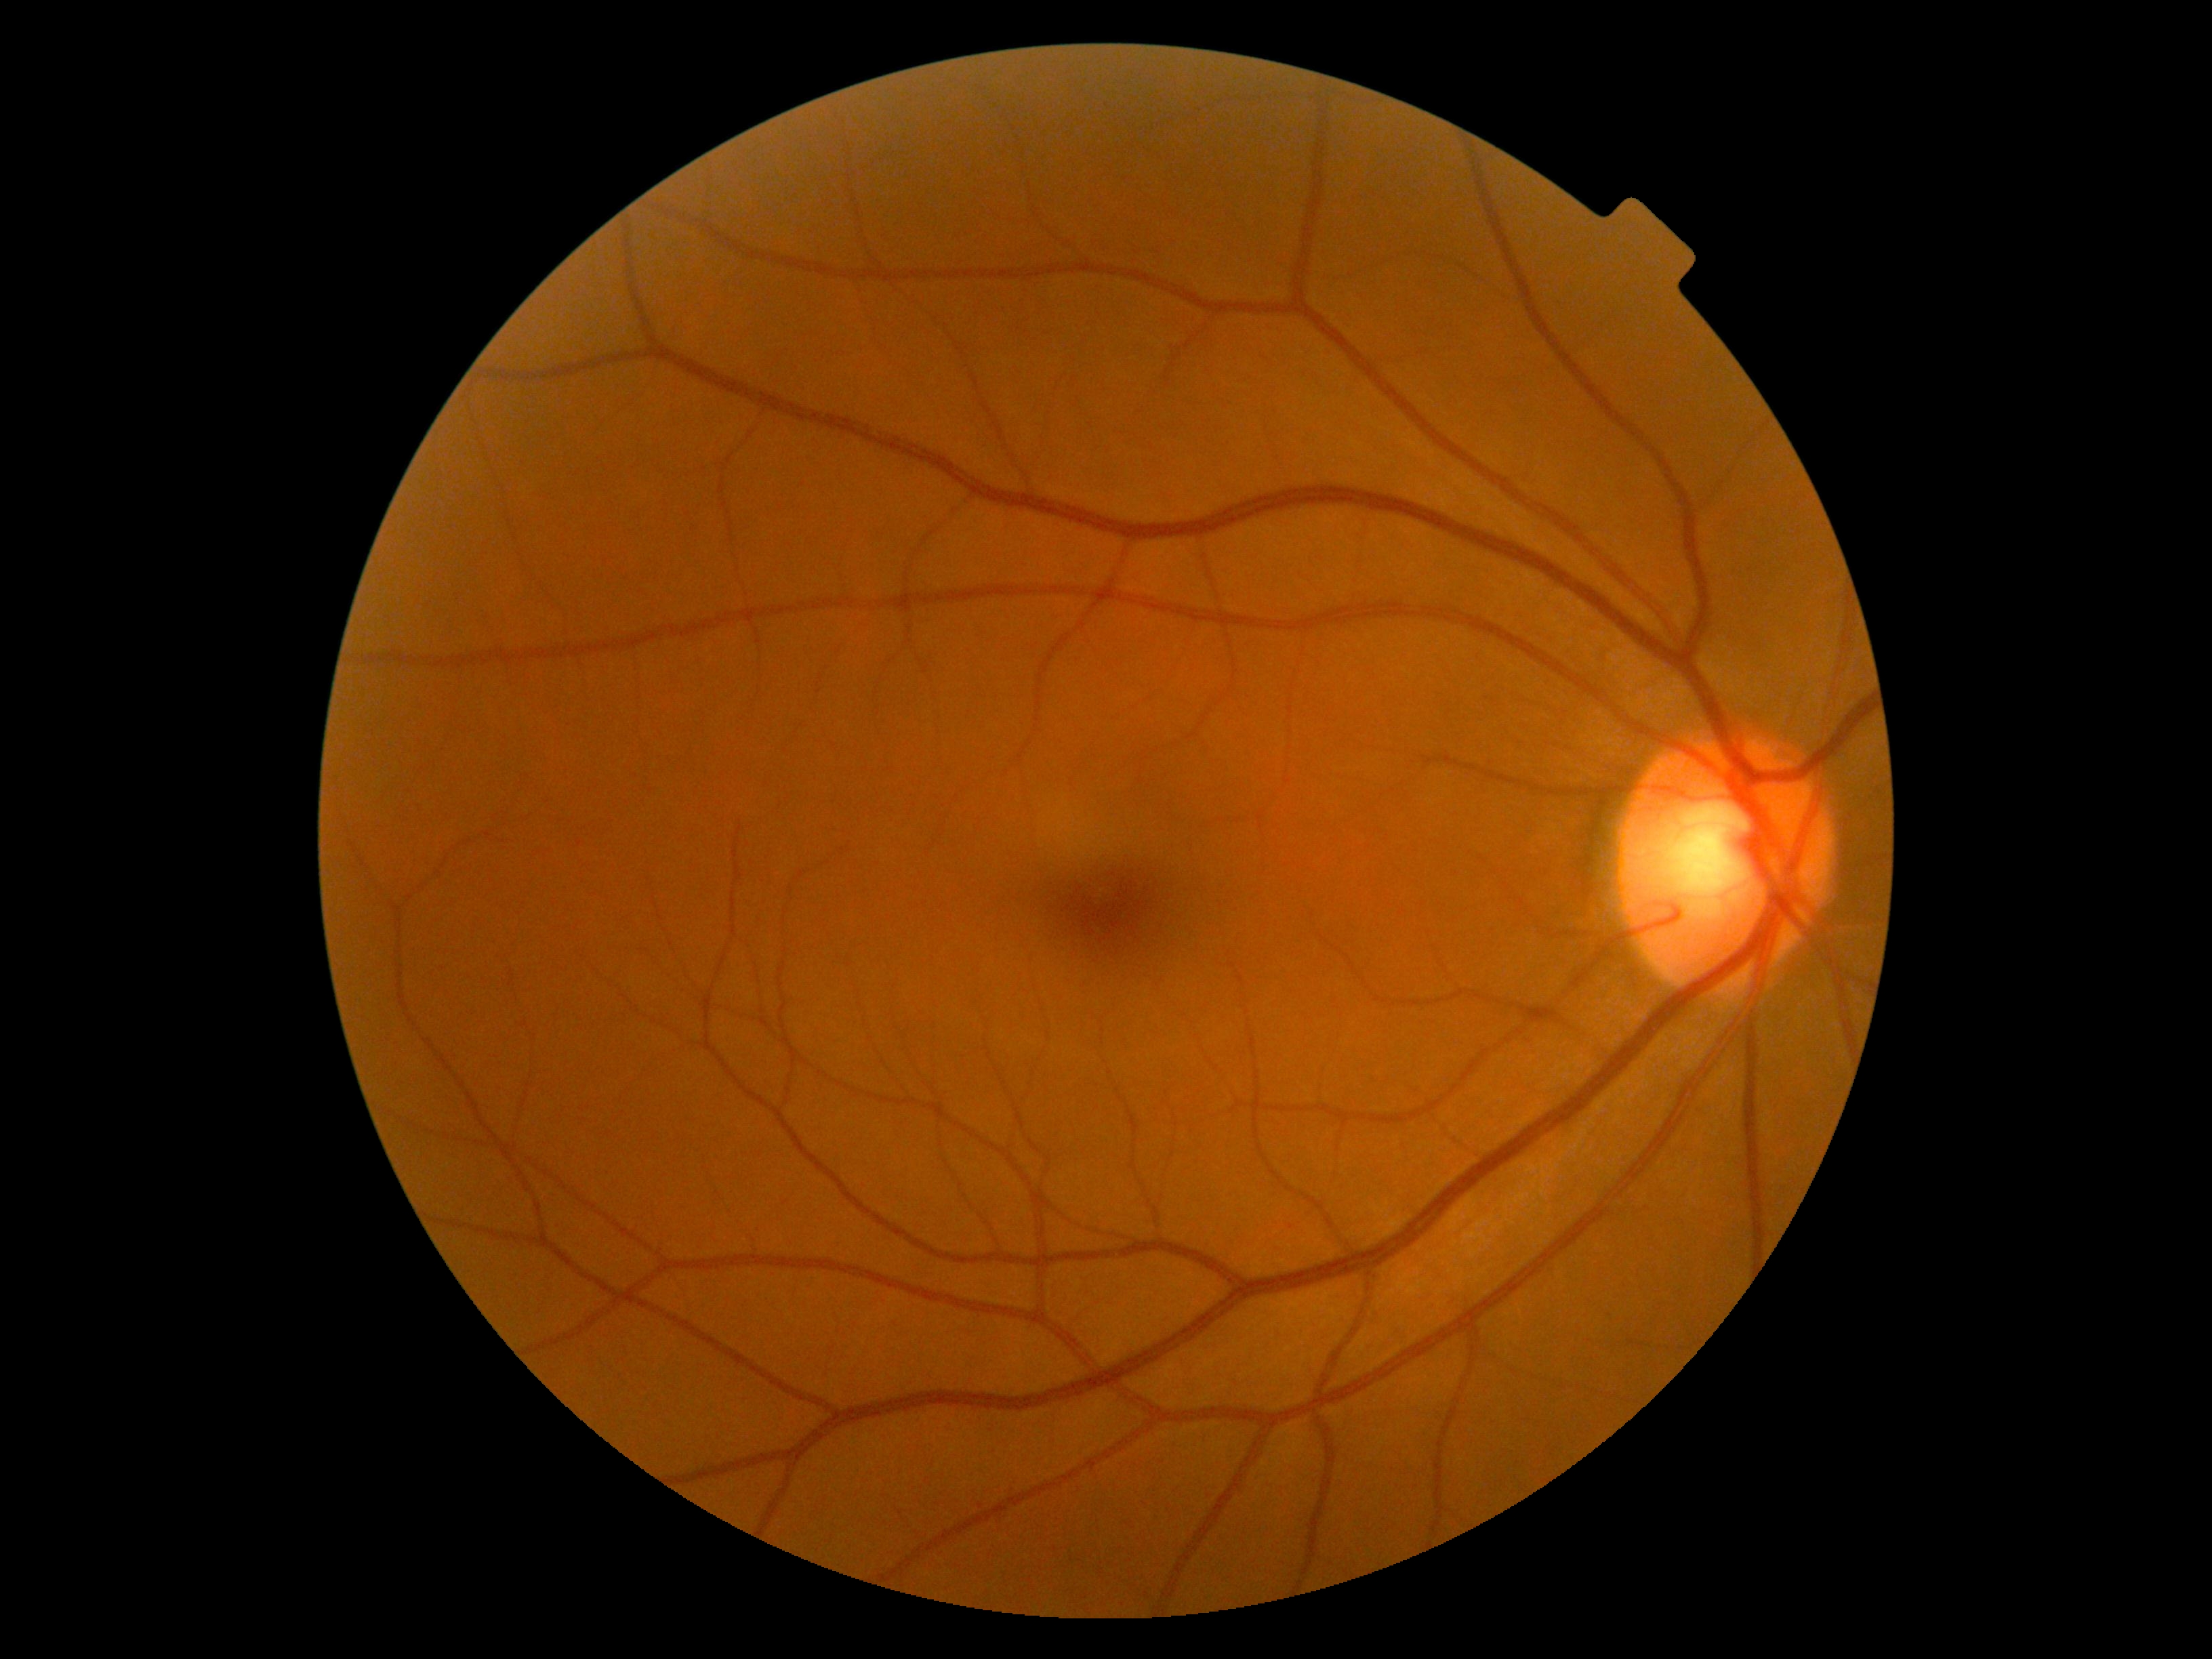 {
  "dr_grade": "no apparent diabetic retinopathy (0)"
}